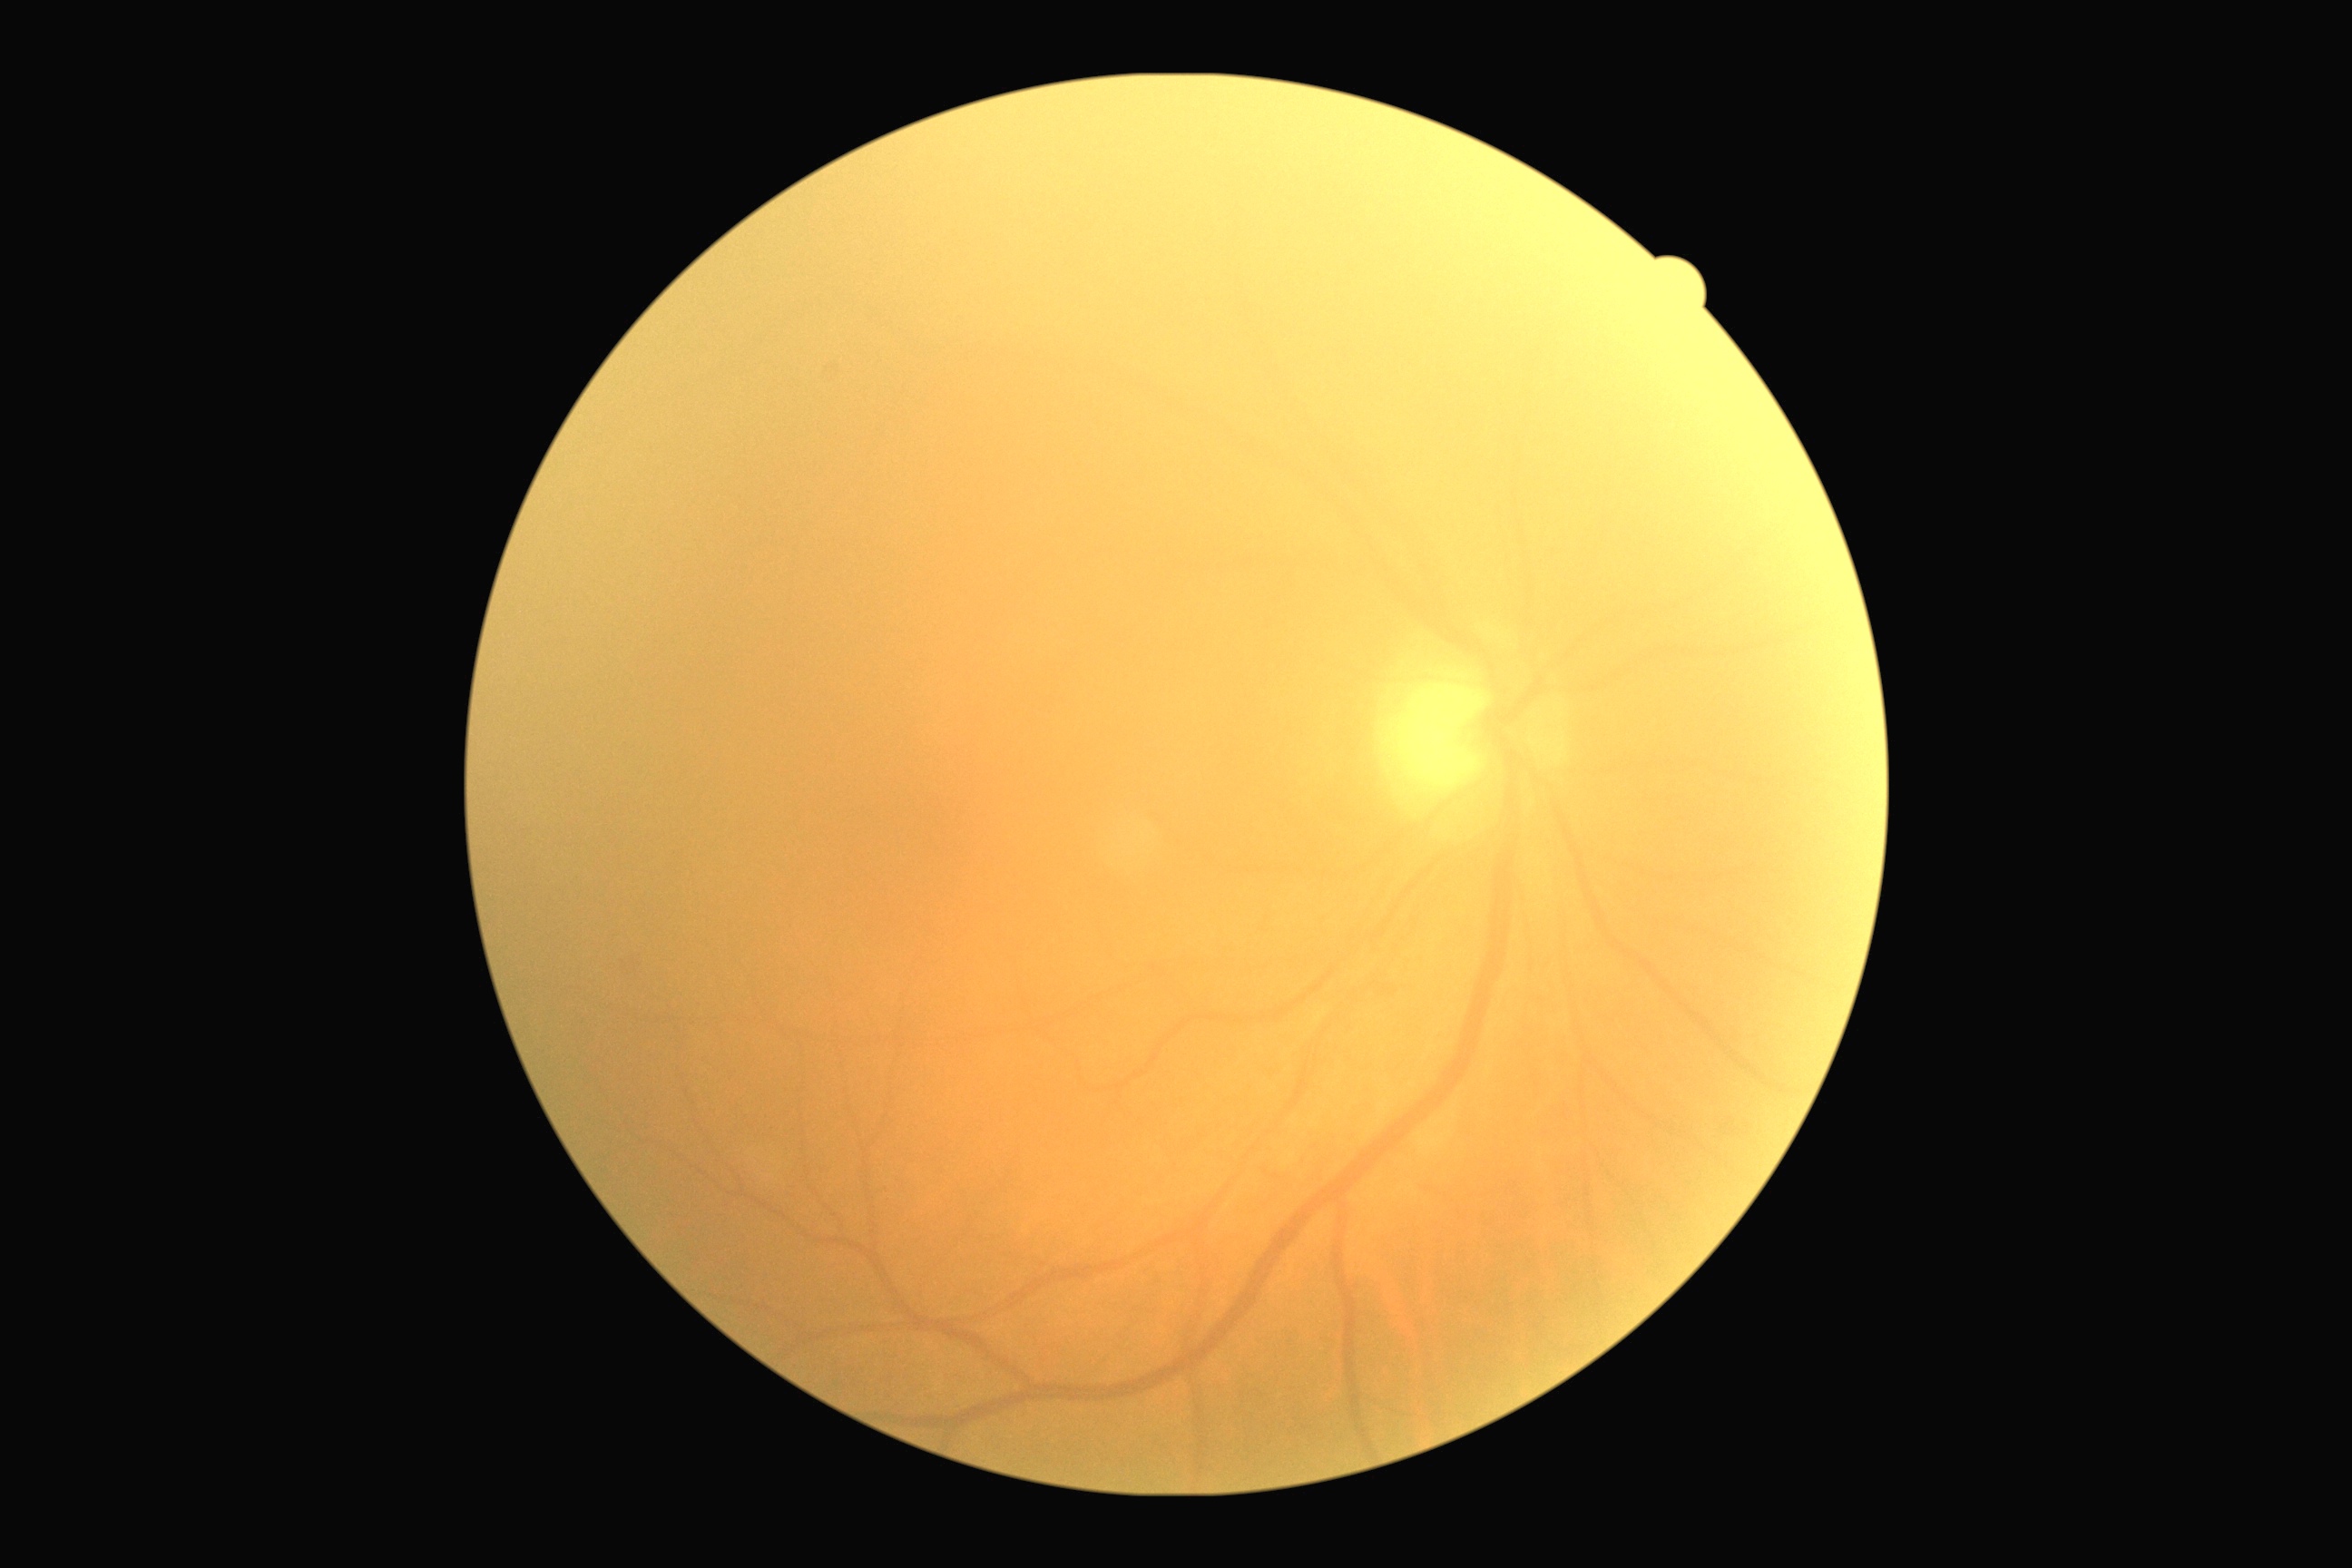 Retinopathy grade: 0 (no apparent retinopathy).